Nonmydriatic · posterior pole photograph · acquired with a NIDEK AFC-230 · 45° field of view · Davis DR grading:
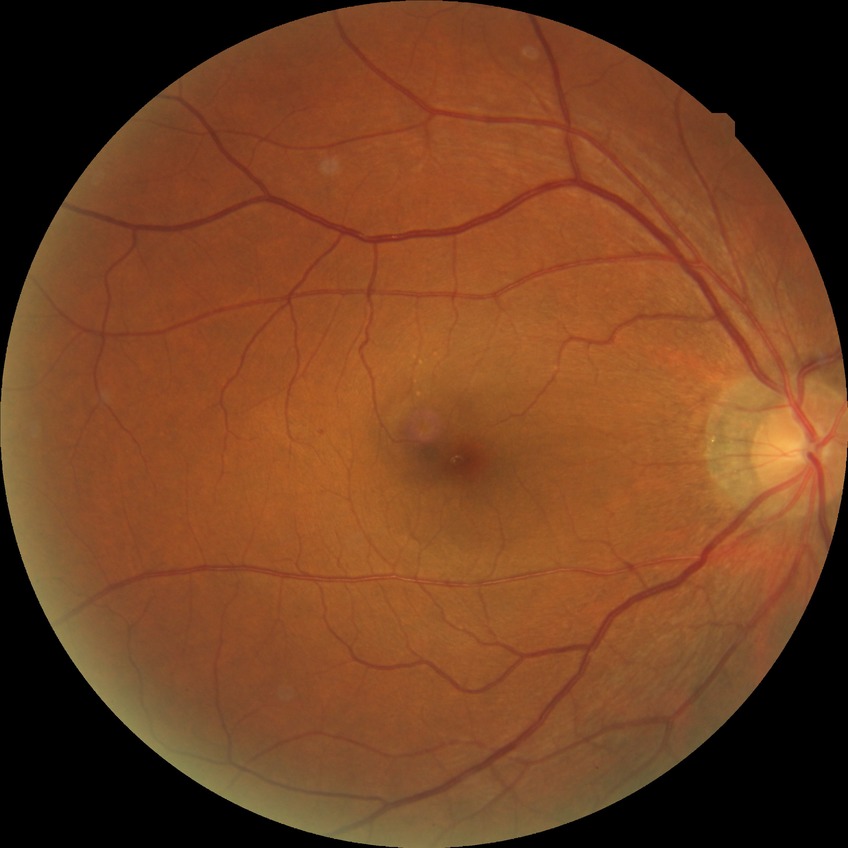

DR is NDR.